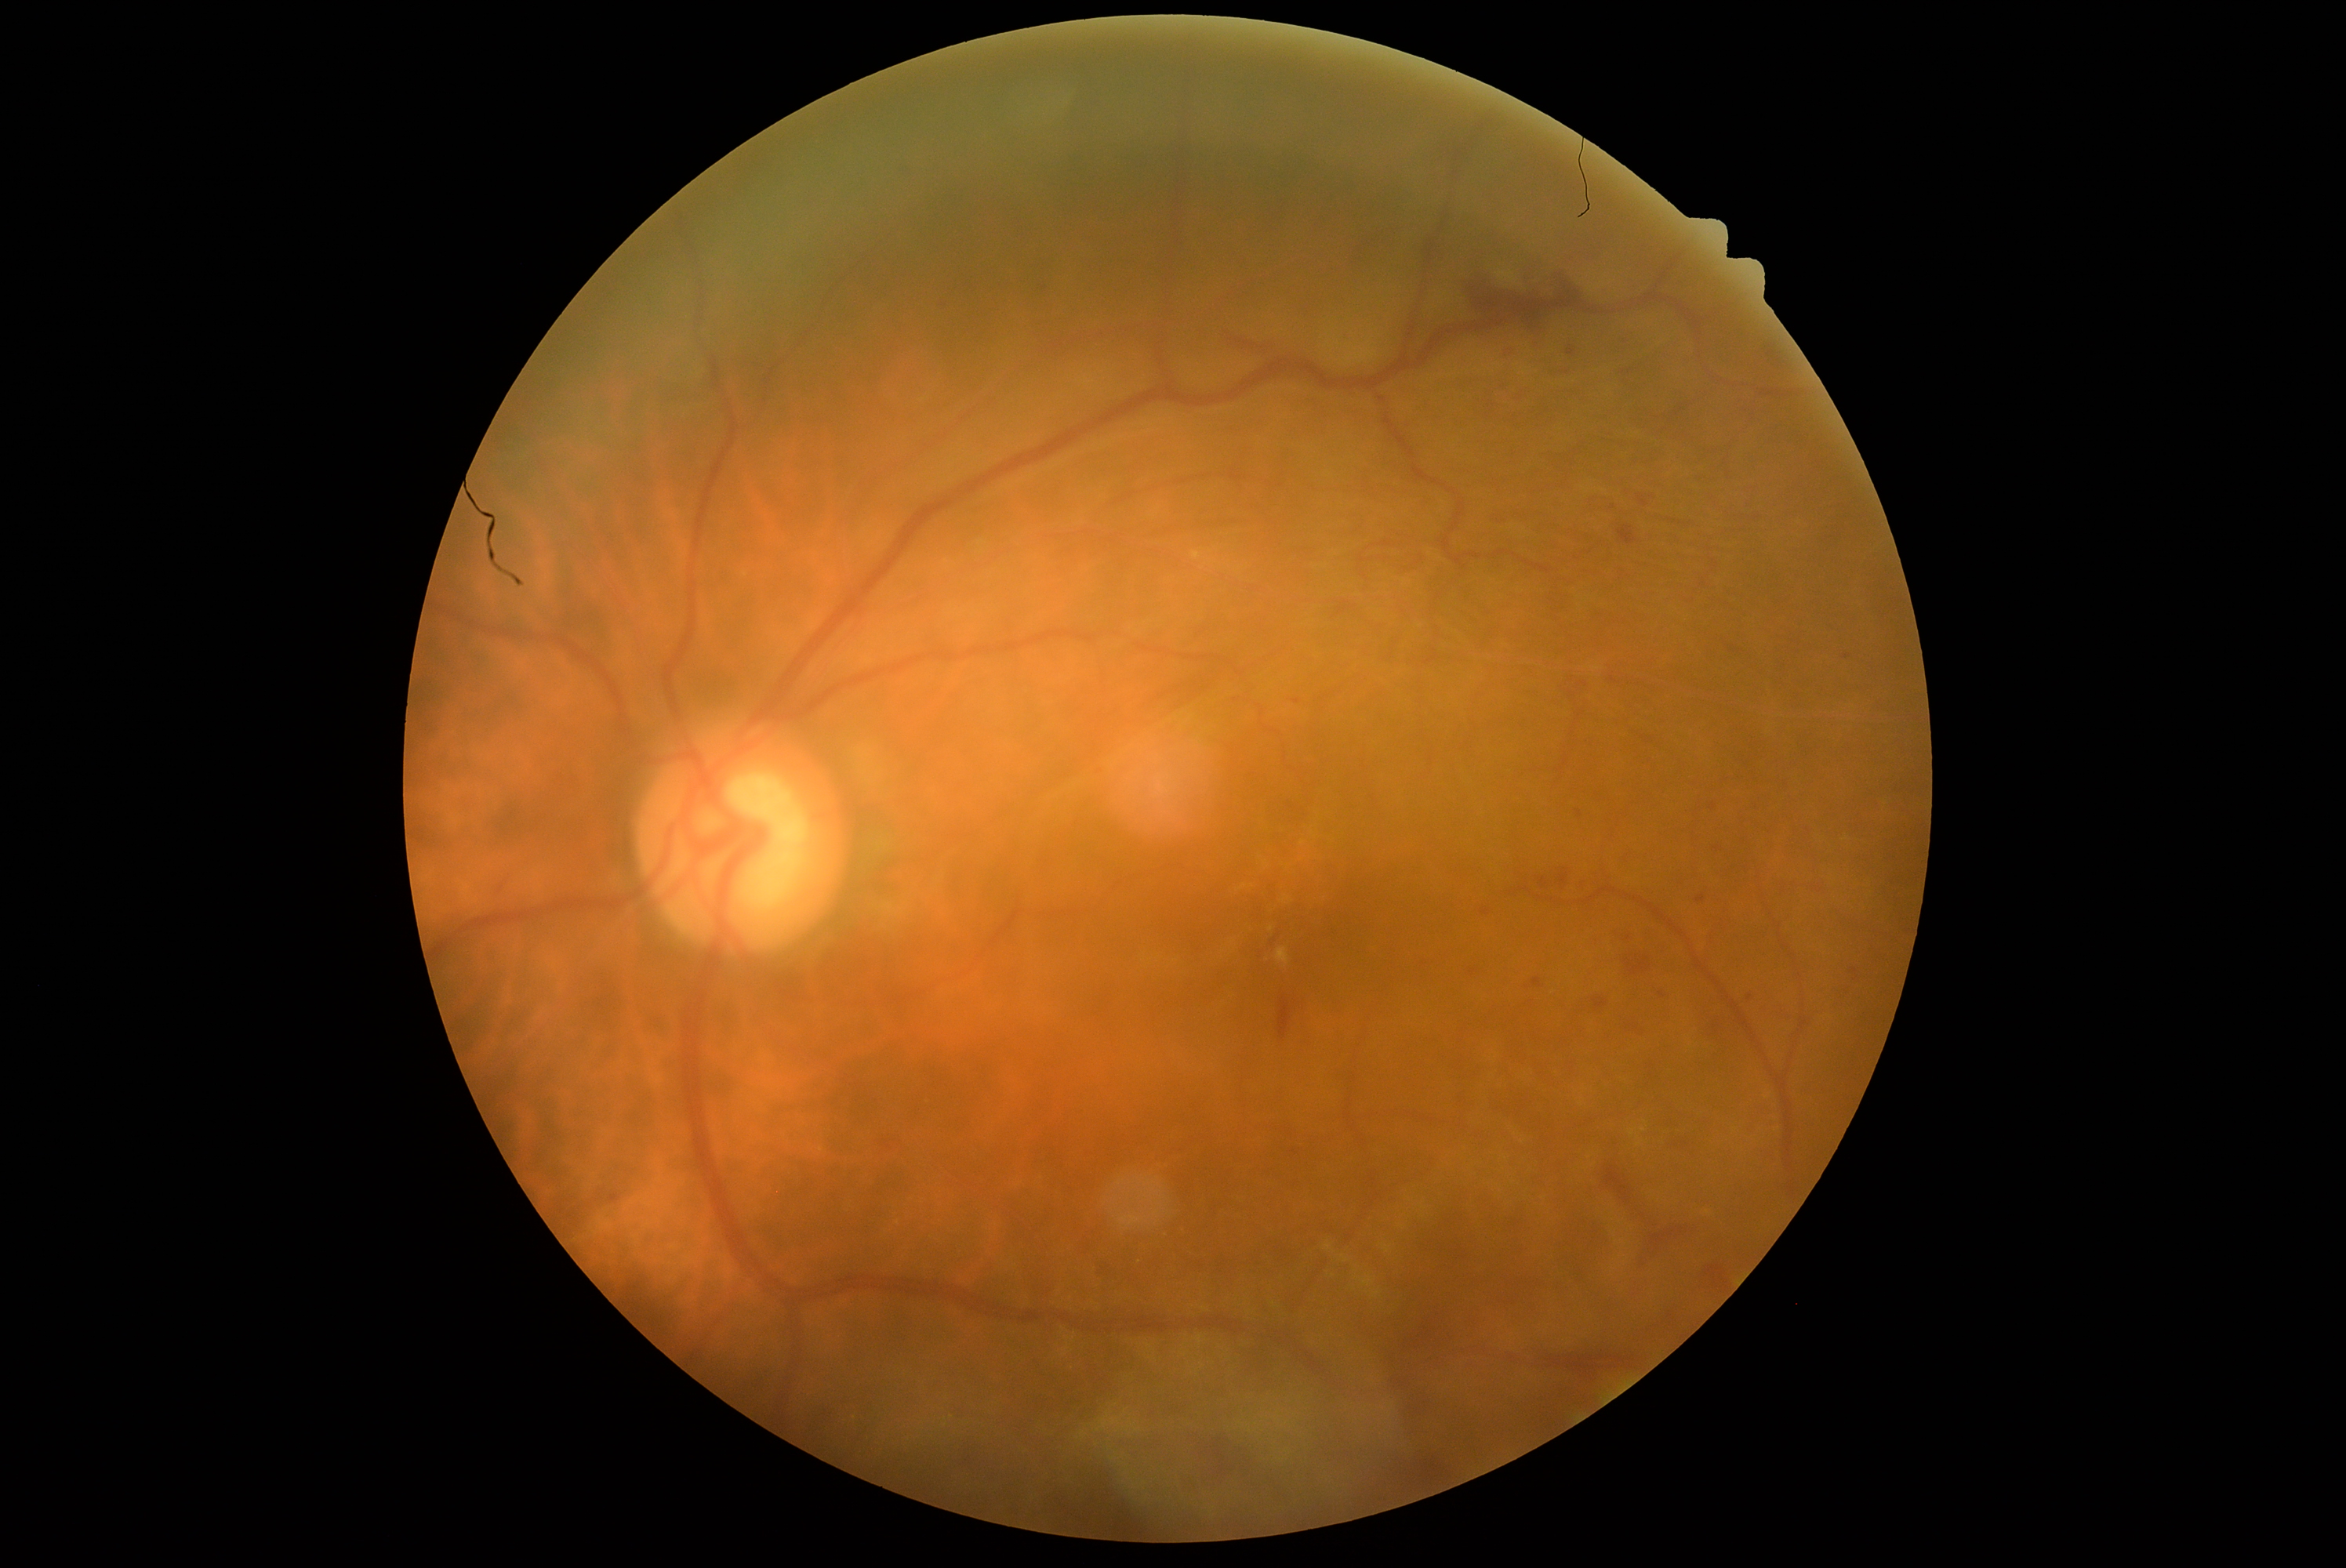

Diabetic retinopathy (DR): grade 2. Hemorrhages (HEs) include Rect(1613, 931, 1633, 946); Rect(1538, 877, 1549, 890); Rect(1641, 929, 1674, 954); Rect(1547, 366, 1574, 379); Rect(1698, 1015, 1737, 1045); Rect(1500, 344, 1514, 357); Rect(1089, 1261, 1120, 1280); Rect(1481, 909, 1491, 916); Rect(1216, 332, 1280, 360); Rect(1030, 277, 1051, 299); Rect(1279, 995, 1293, 1039). Additional small HEs near {"x": 1848, "y": 657}; {"x": 1663, "y": 995}.